Acquired with a NIDEK AFC-230.
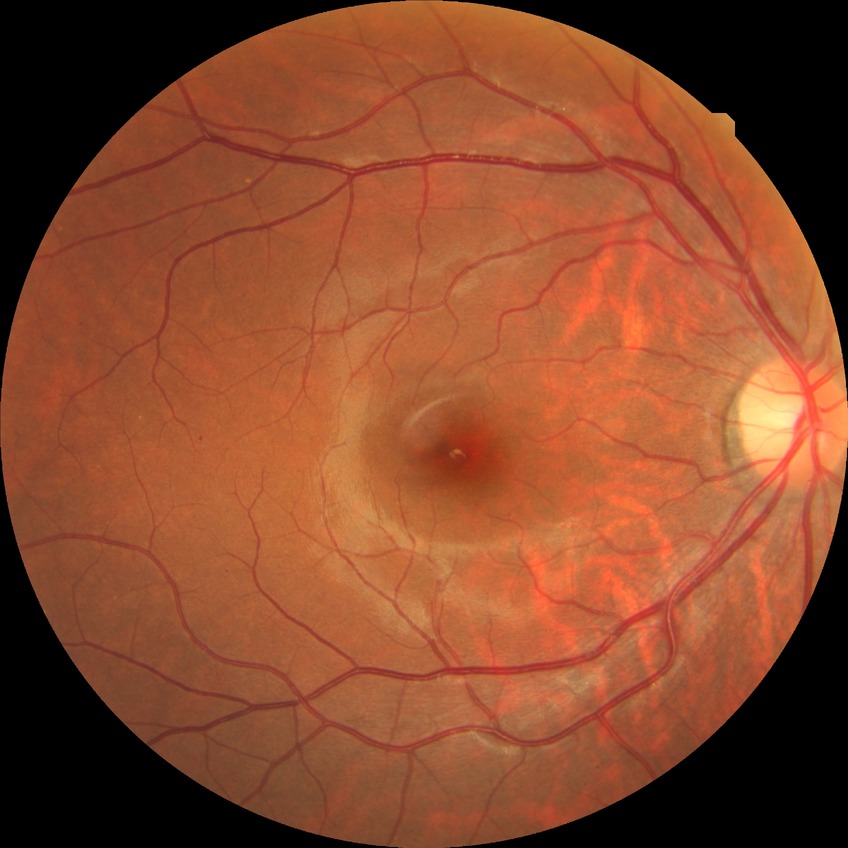
DR class: non-proliferative diabetic retinopathy.
Diabetic retinopathy (DR) is SDR (simple diabetic retinopathy).